45 degree fundus photograph, camera: NIDEK AFC-230, posterior pole color fundus photograph, 848x848
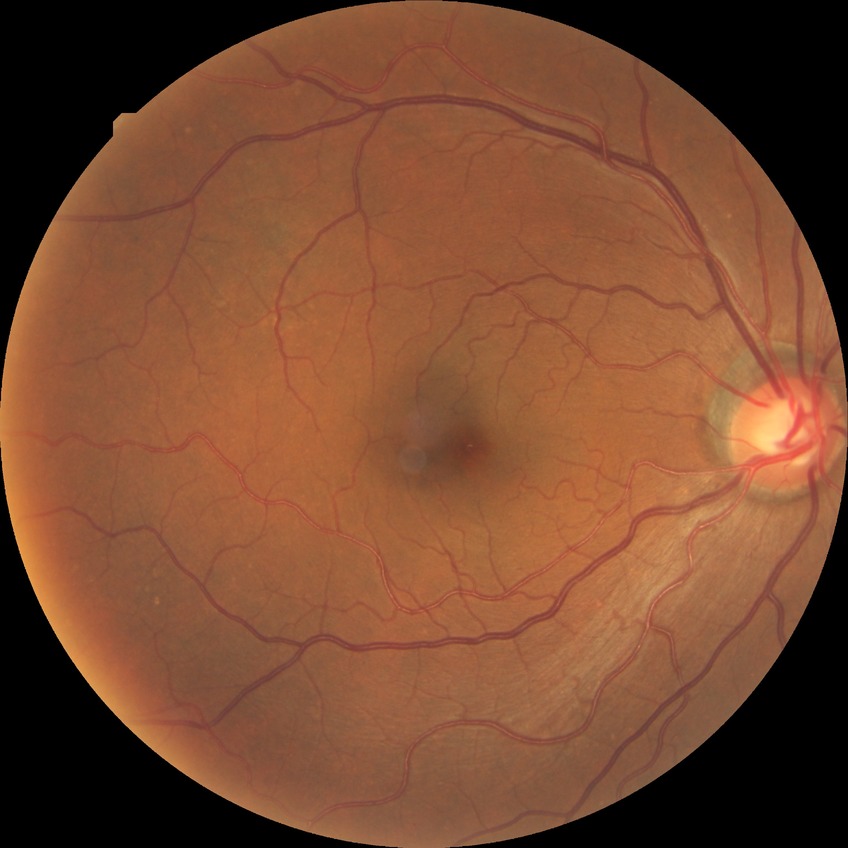

Diabetic retinopathy (DR) is NDR (no diabetic retinopathy).